2048x1536; 45° FOV.
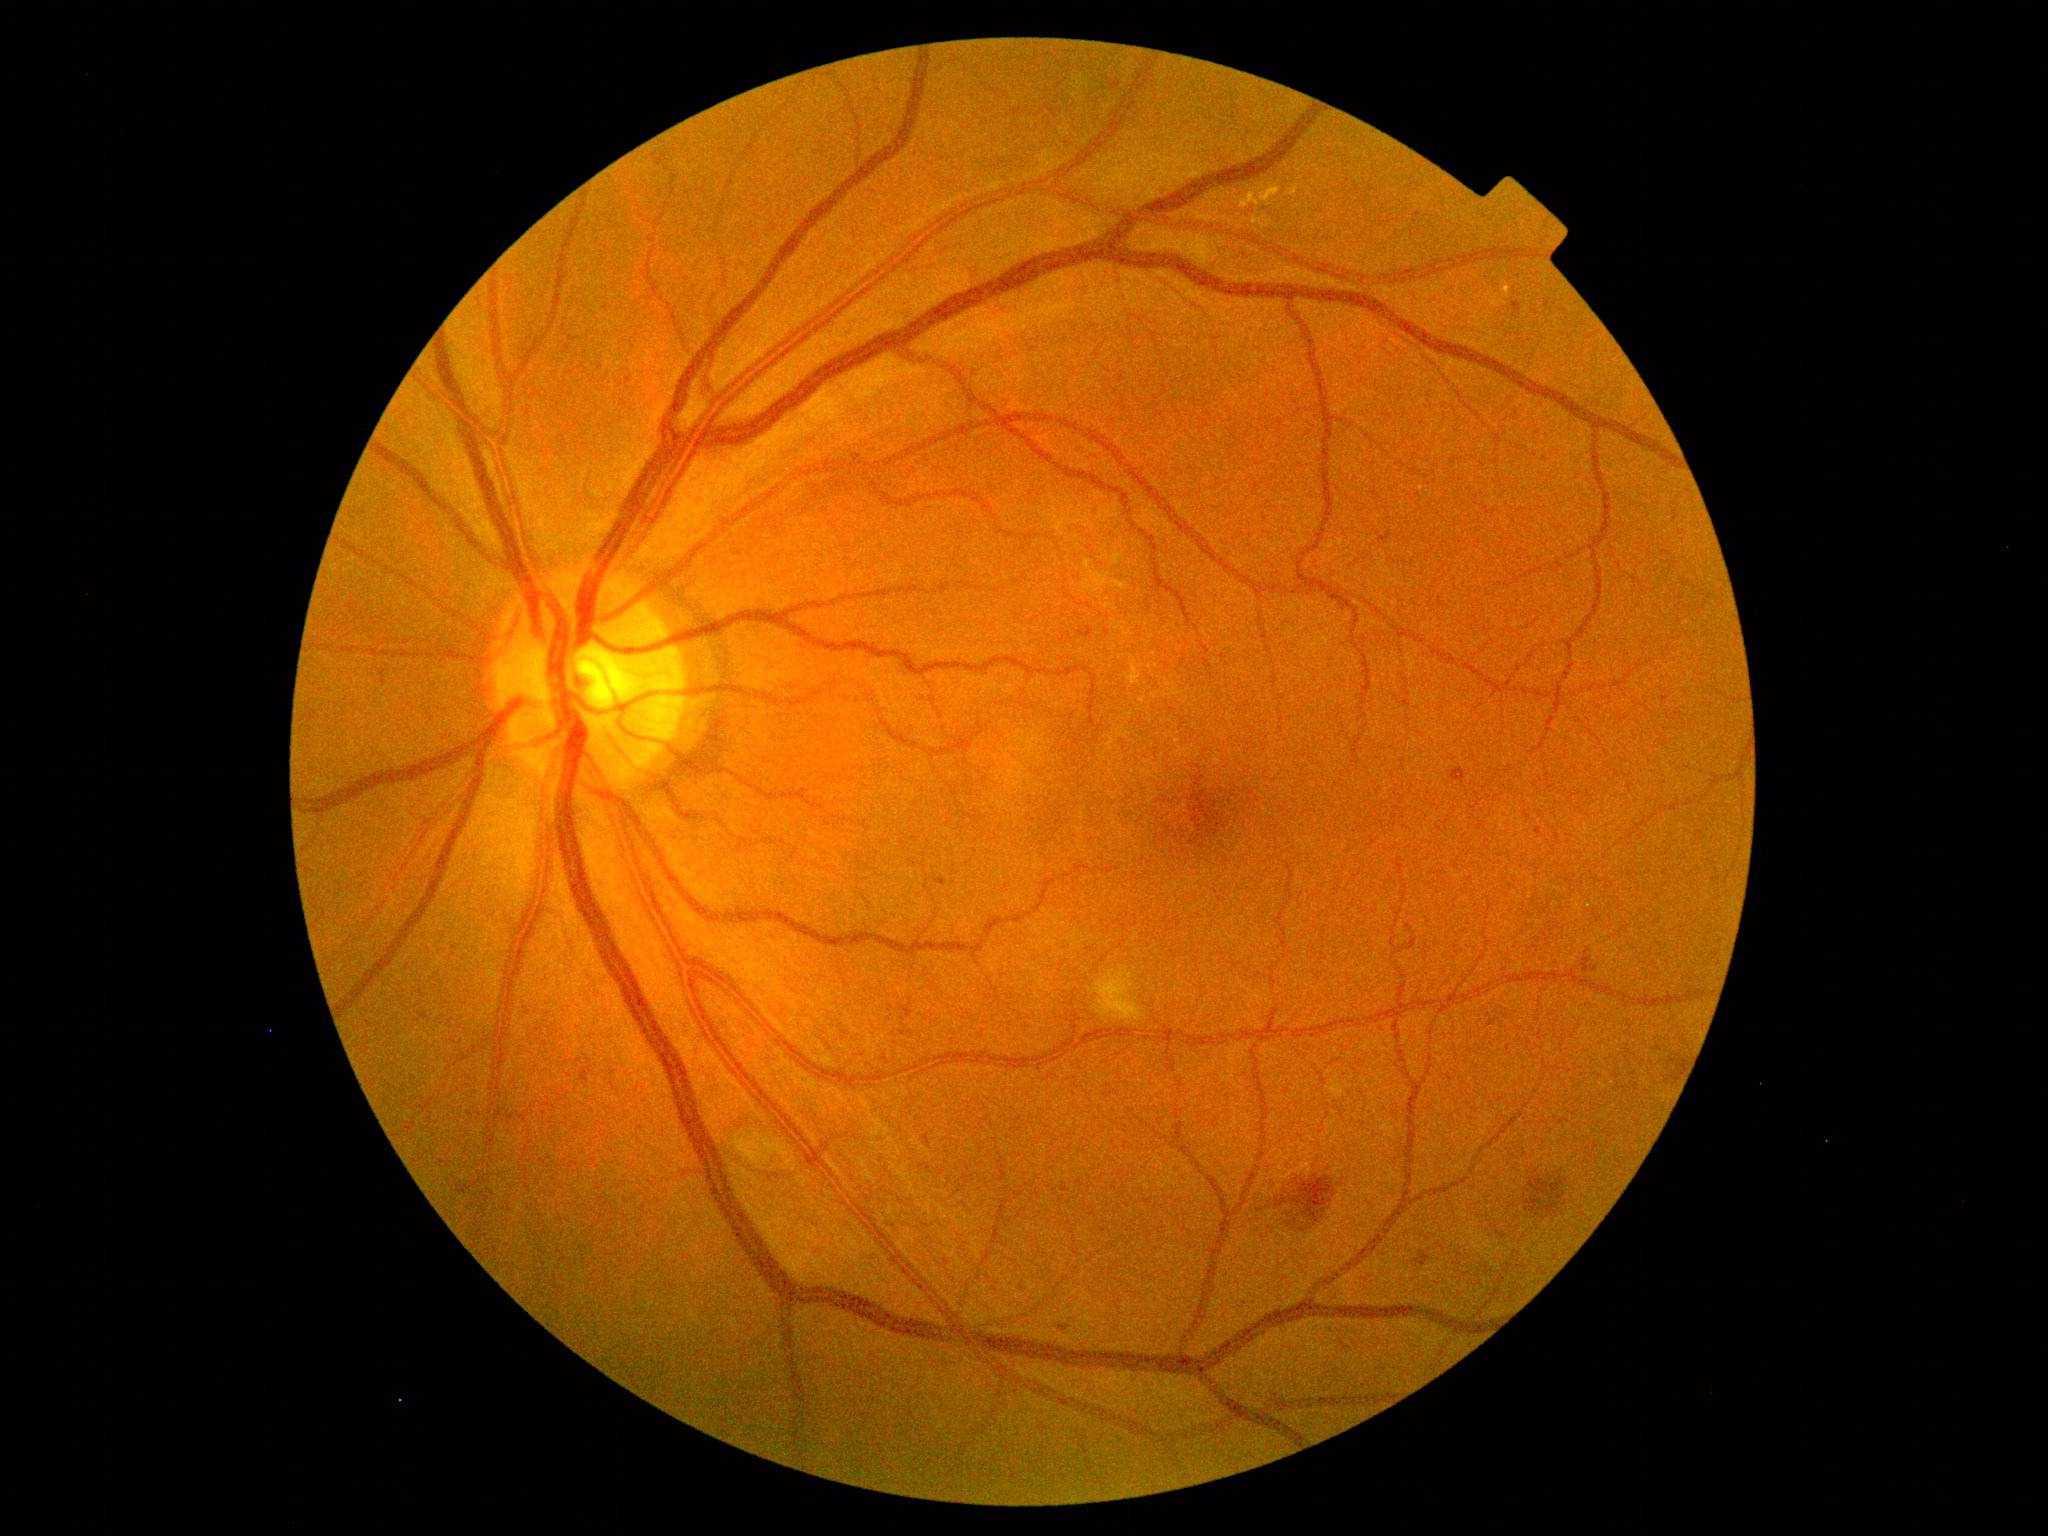

{"dr_grade": "2 (moderate NPDR)"}